Wide-field fundus image from infant ROP screening
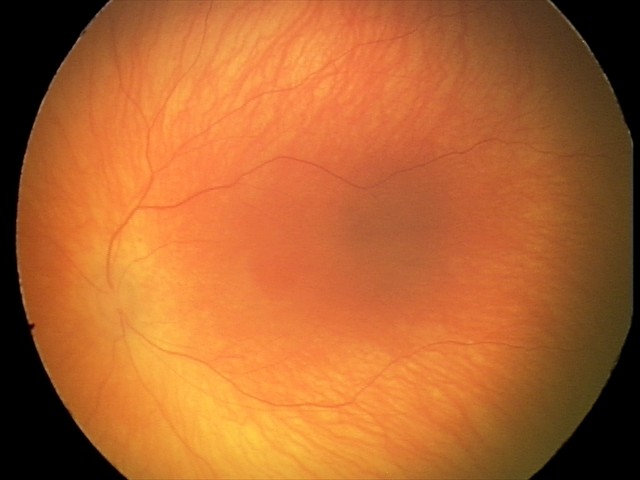

Examination with physiological retinal findings.